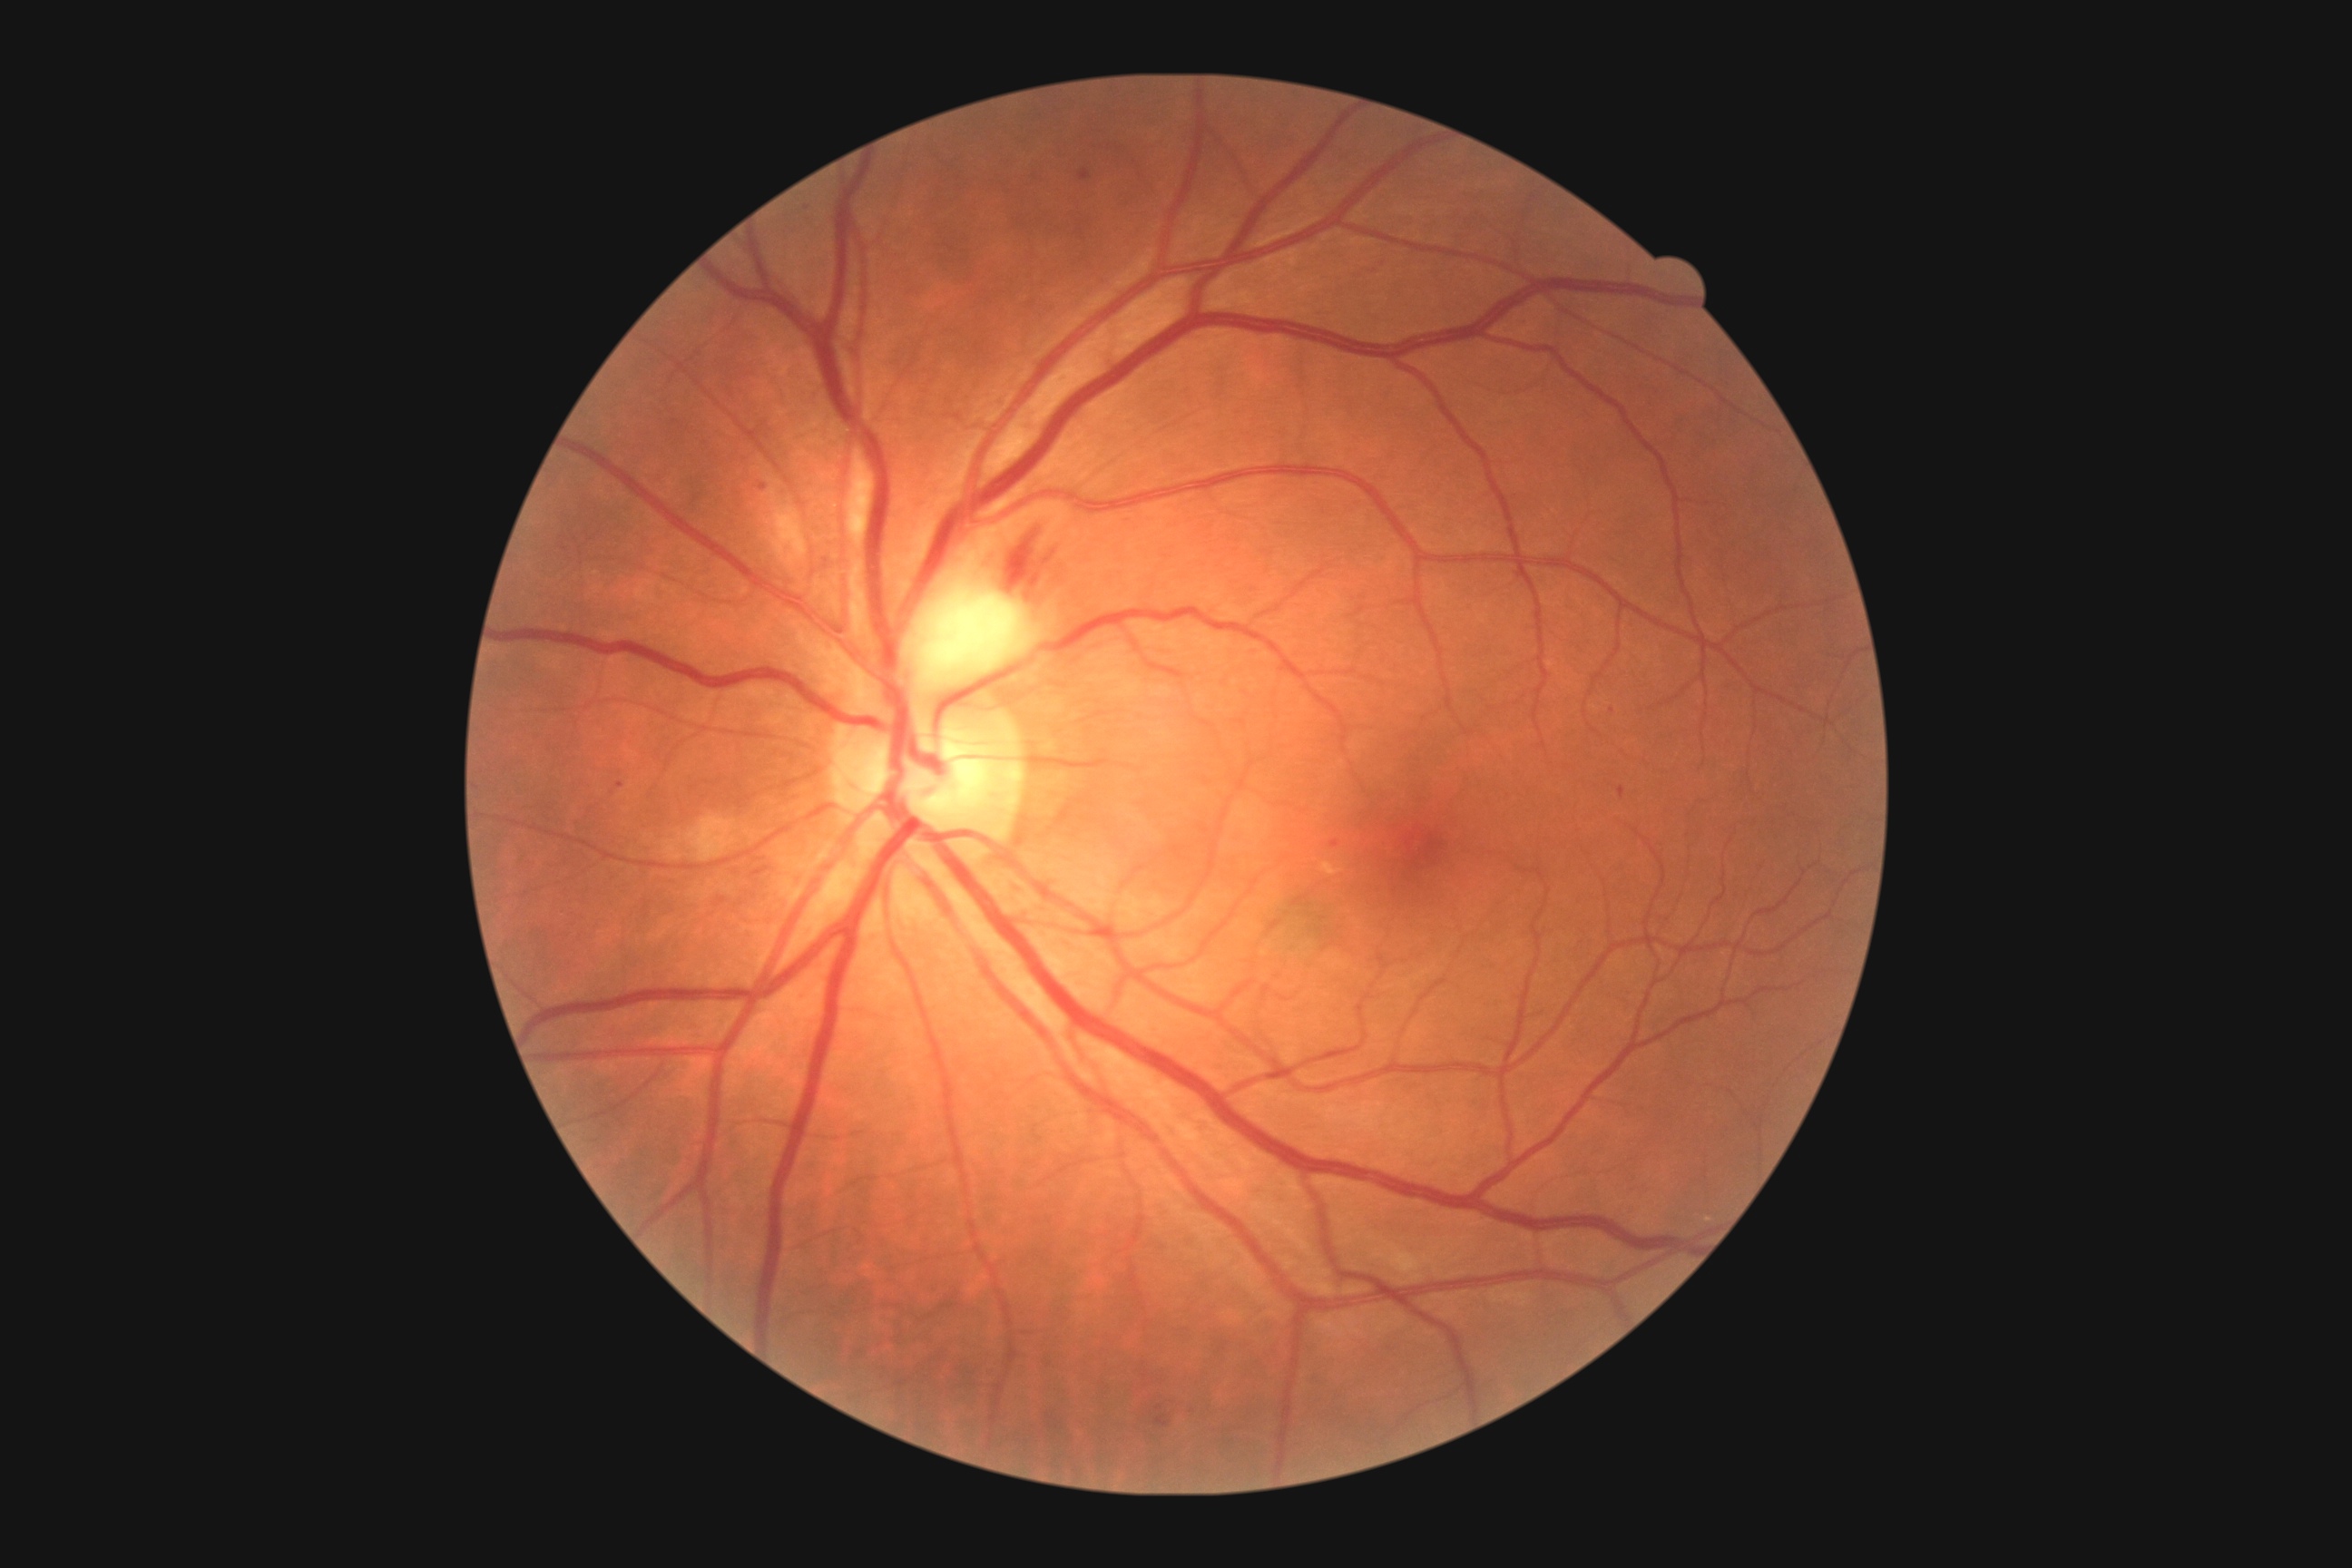

diabetic retinopathy (DR) = grade 2 (moderate NPDR).